Wide-field fundus photograph from neonatal ROP screening.
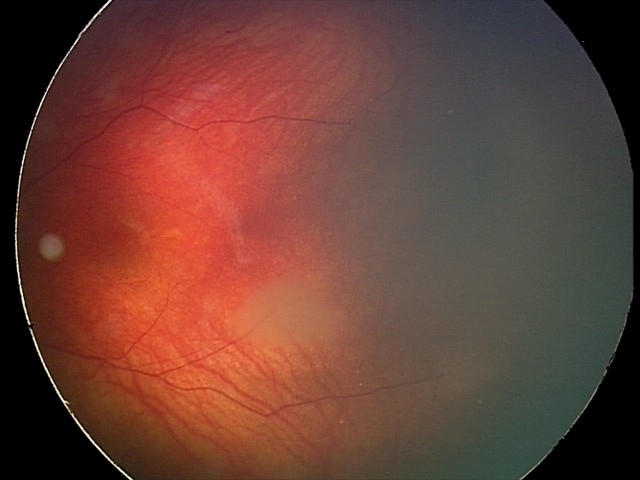

From an examination with diagnosis of retinal astrocytic hamartoma.